45° FOV · image size 2212x1672
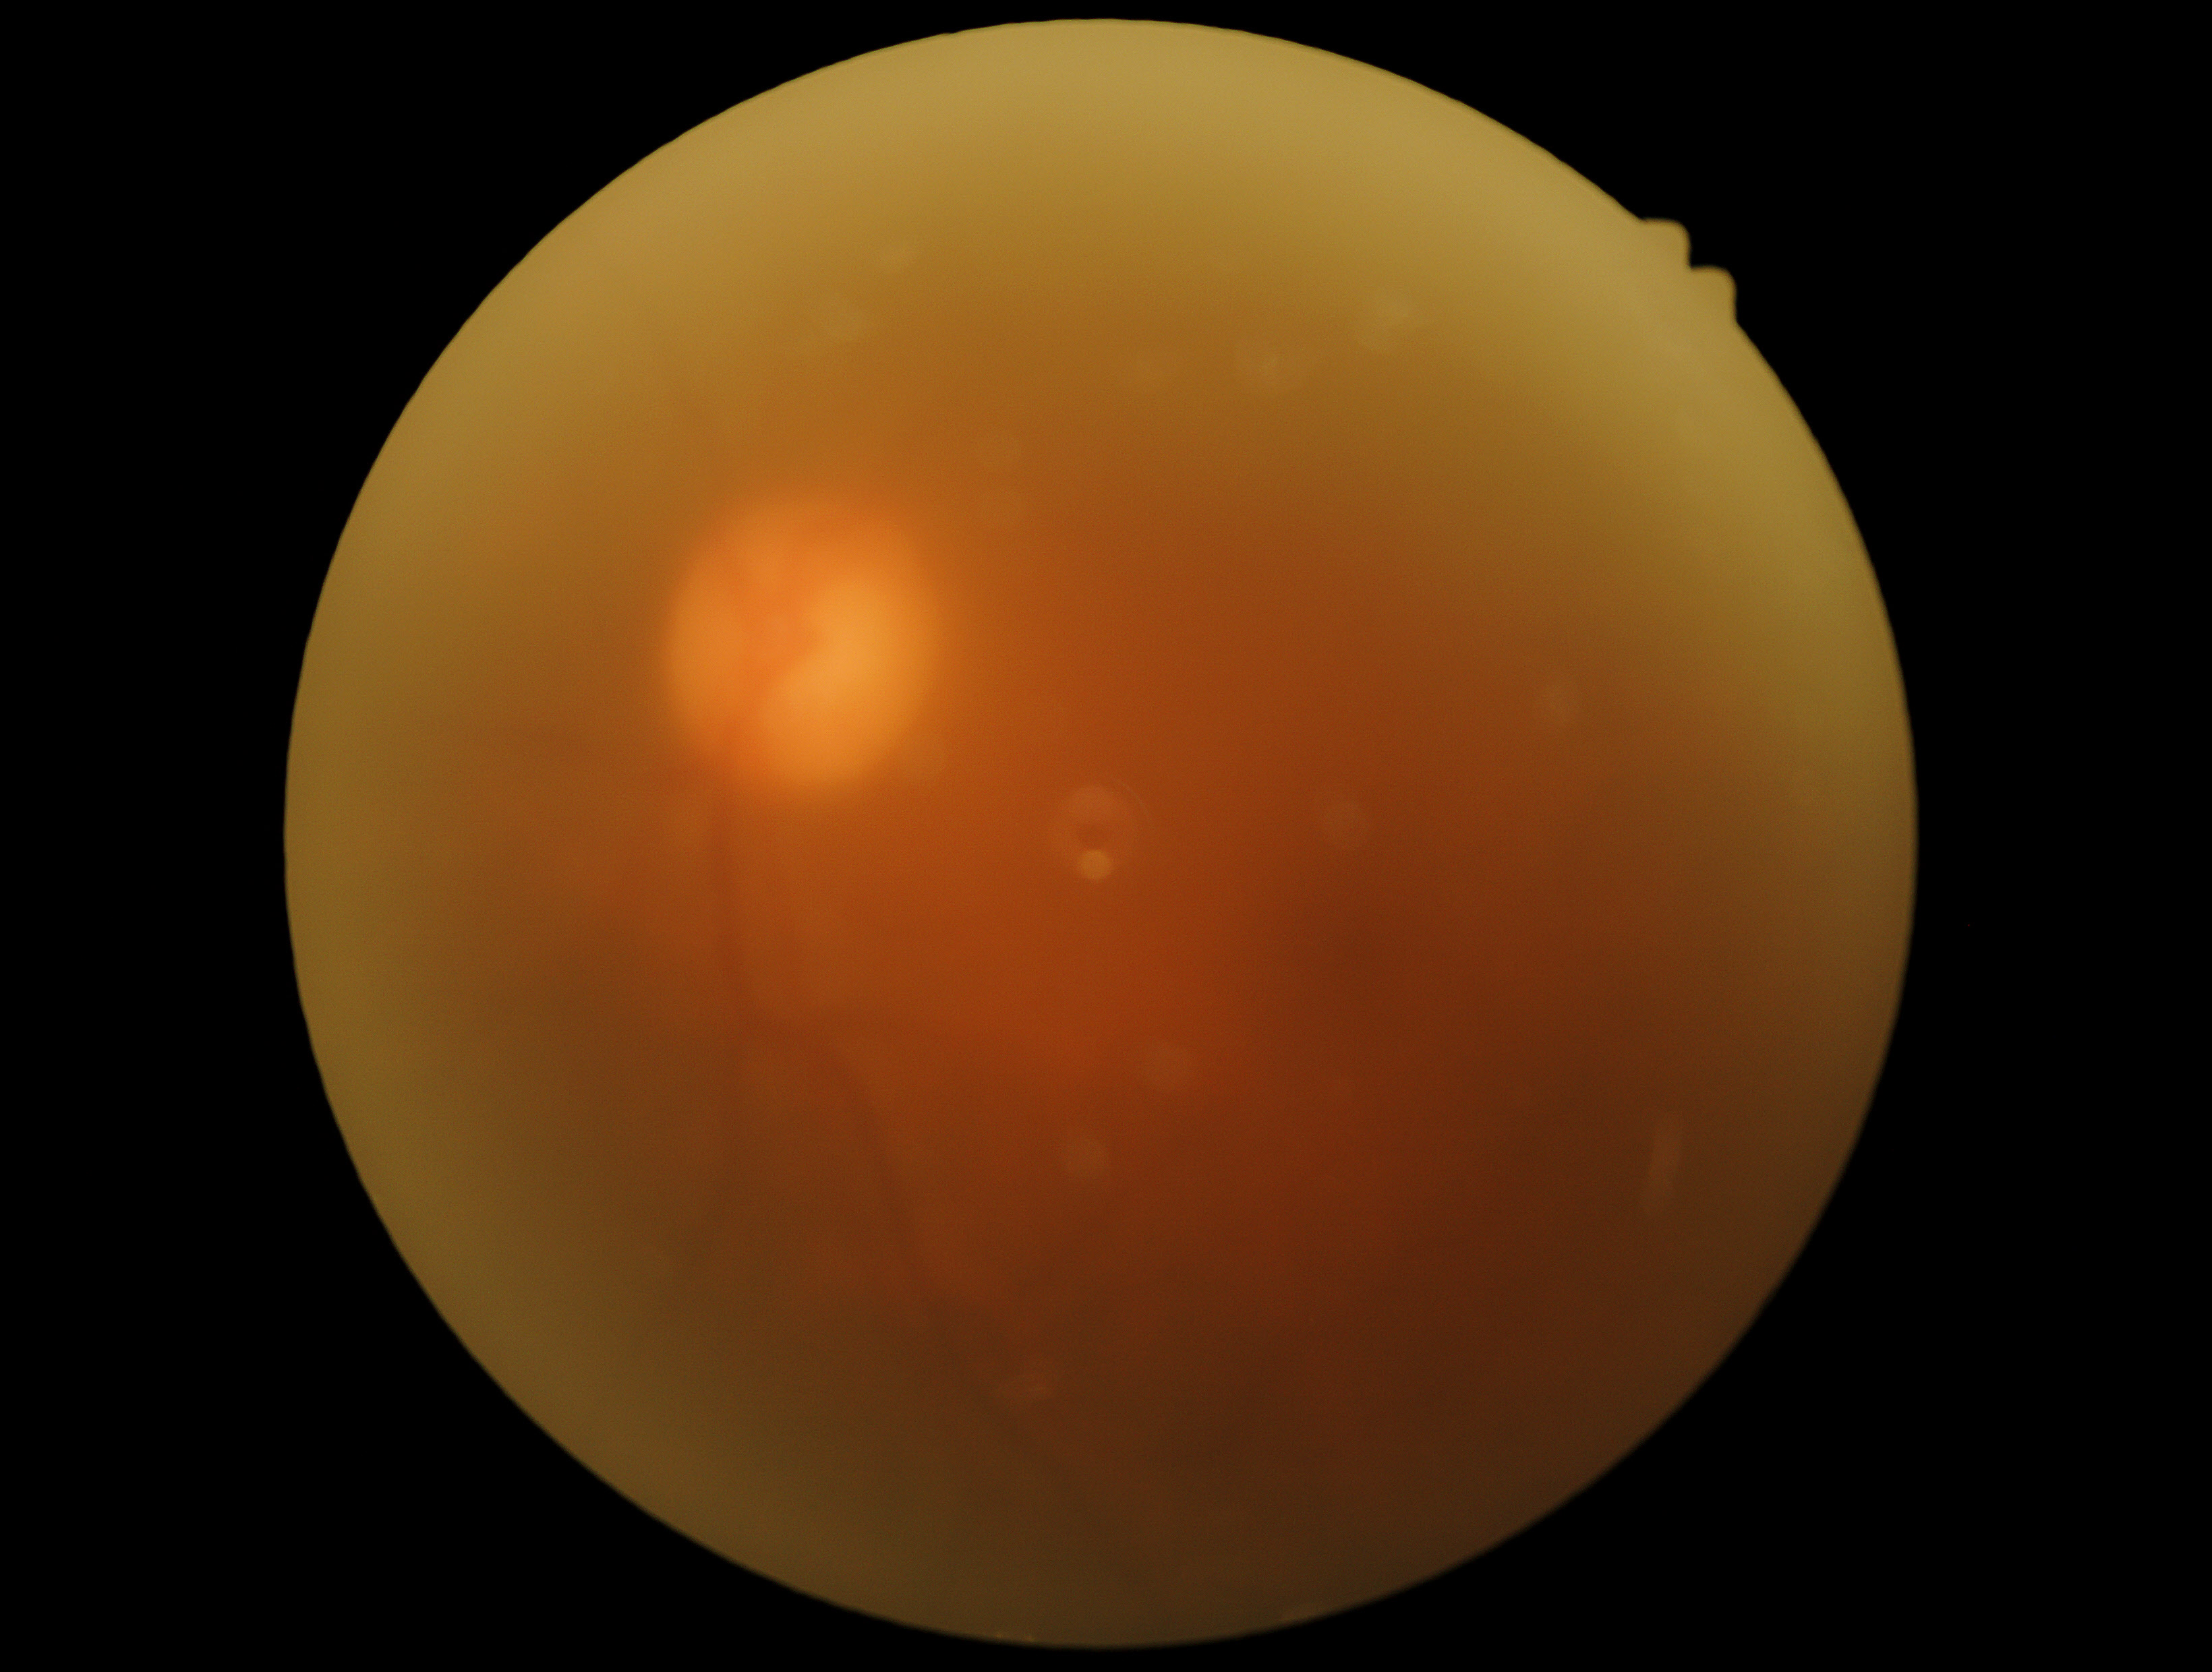

Diabetic retinopathy (DR): ungradable due to poor image quality.